Color fundus image · 2352 x 1568 pixels · 45° field of view:
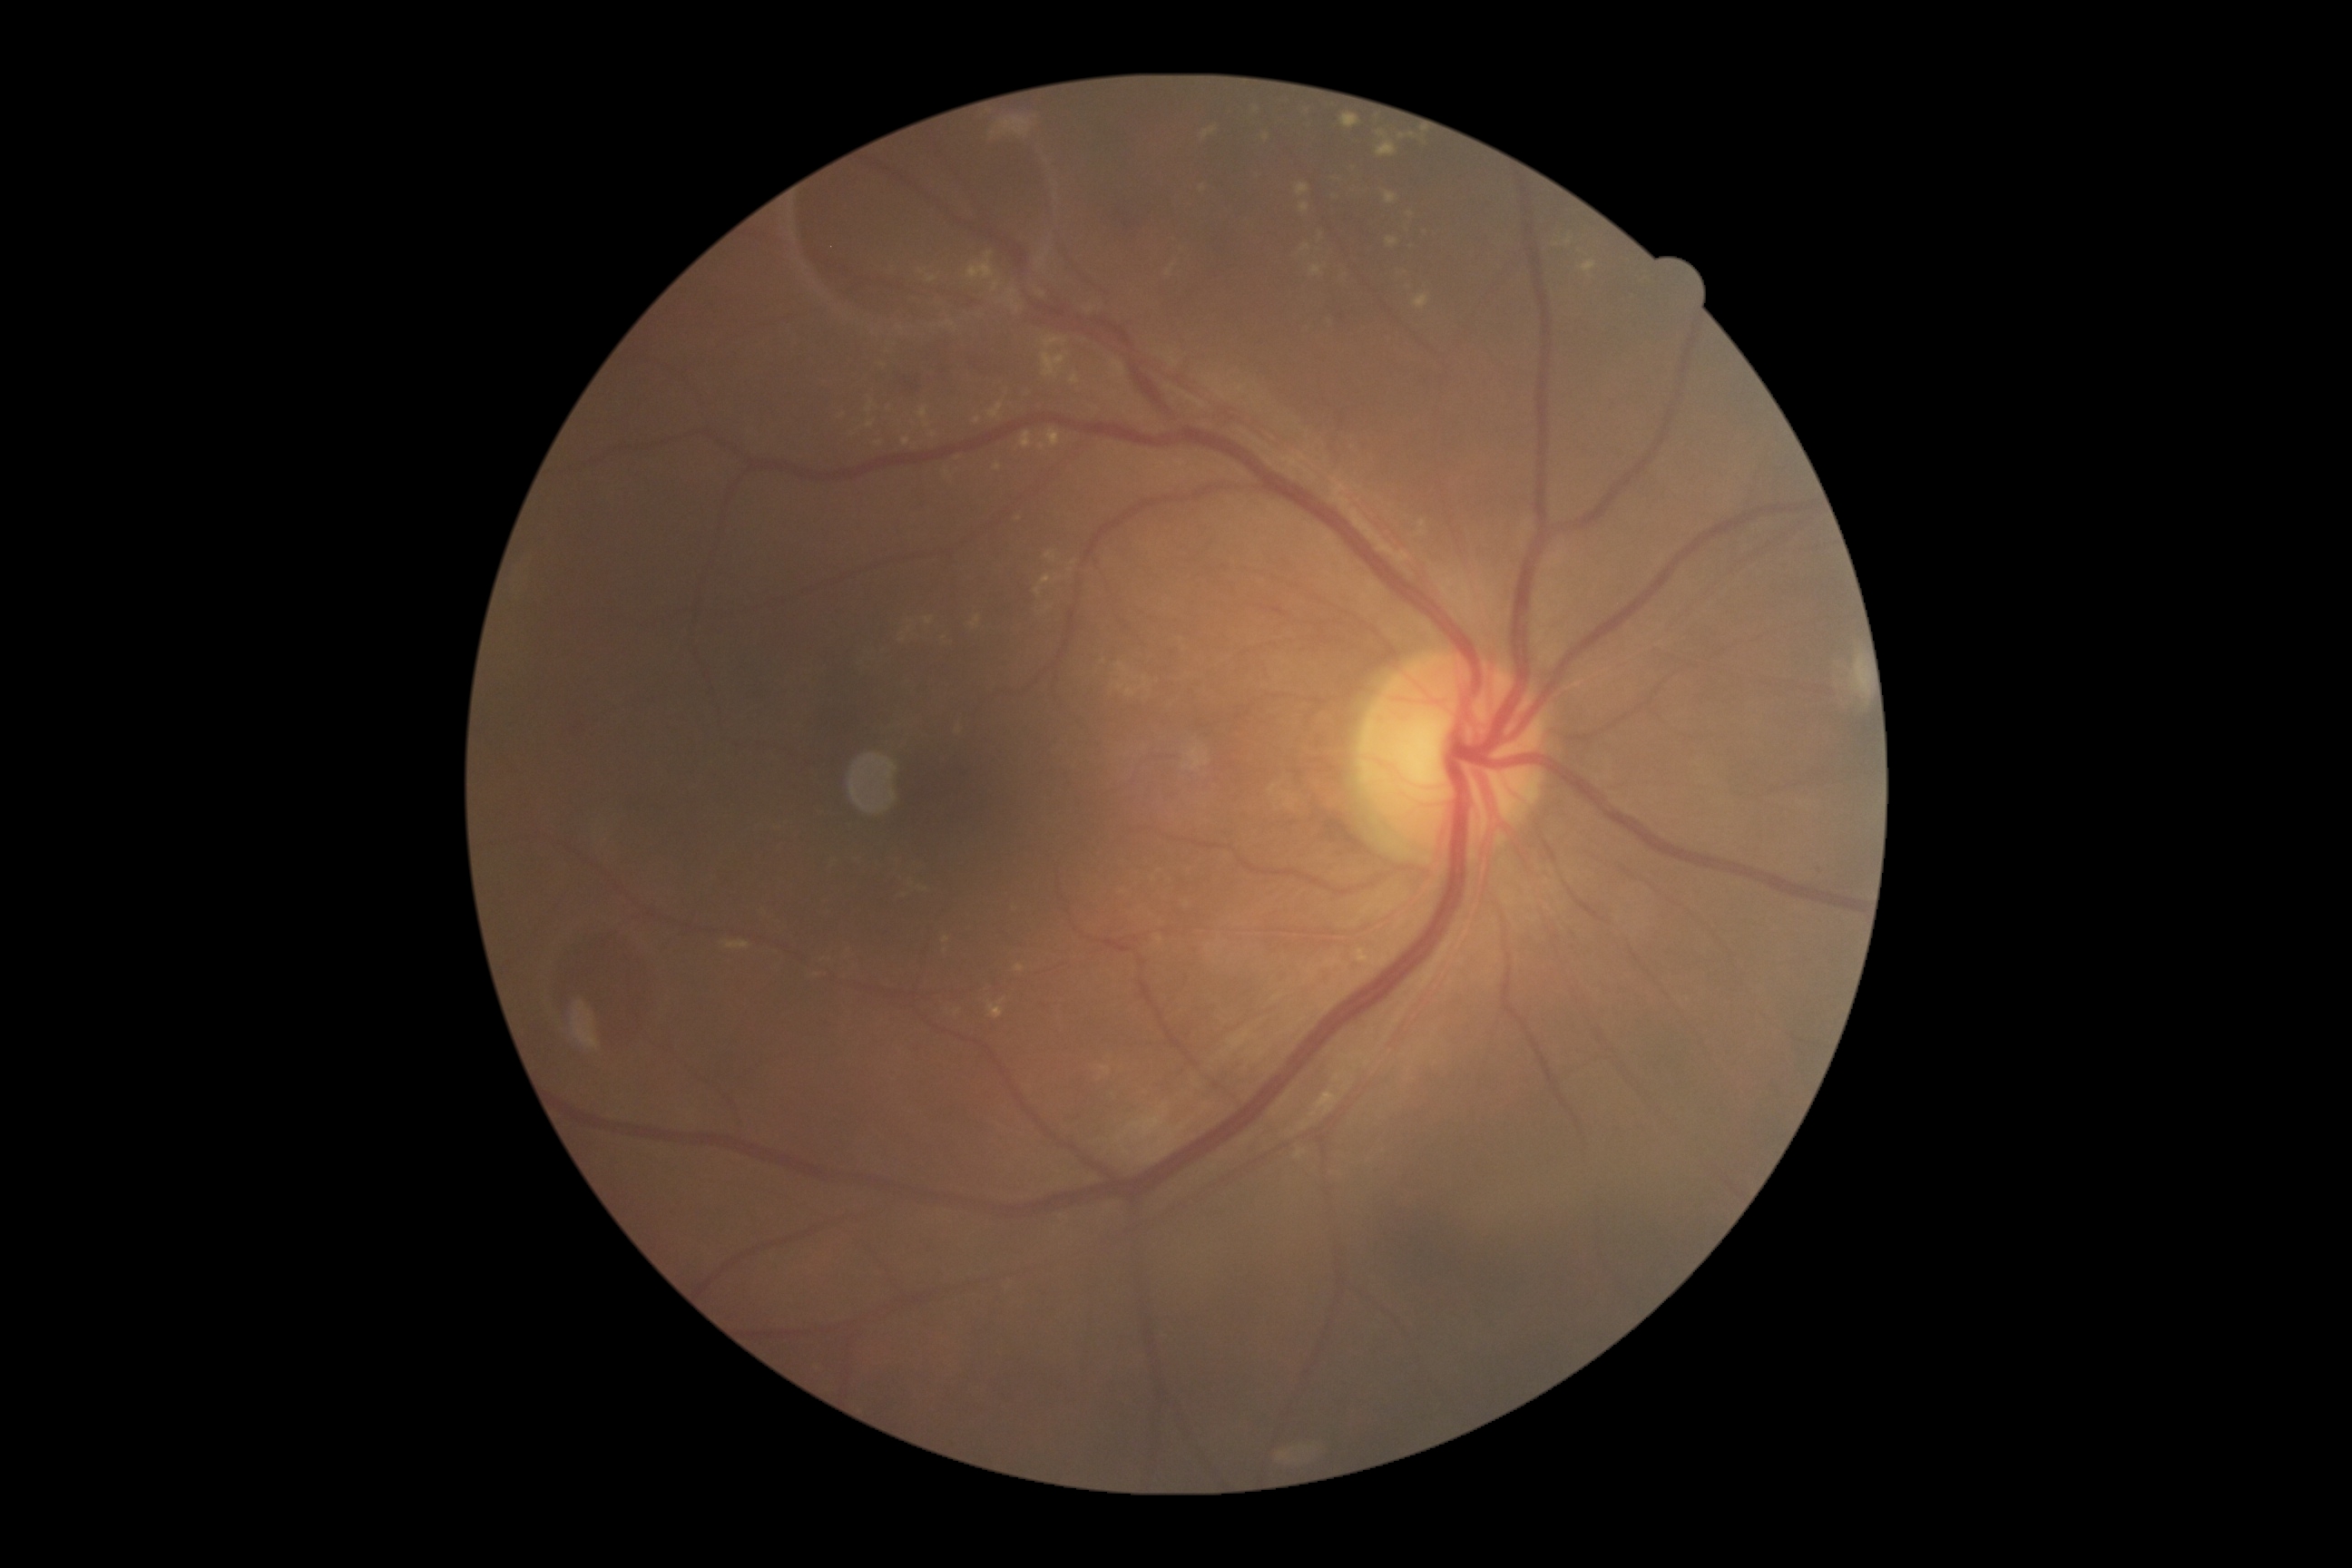 {
  "dr_grade": "2/4"
}